Without pupil dilation; 848x848px.
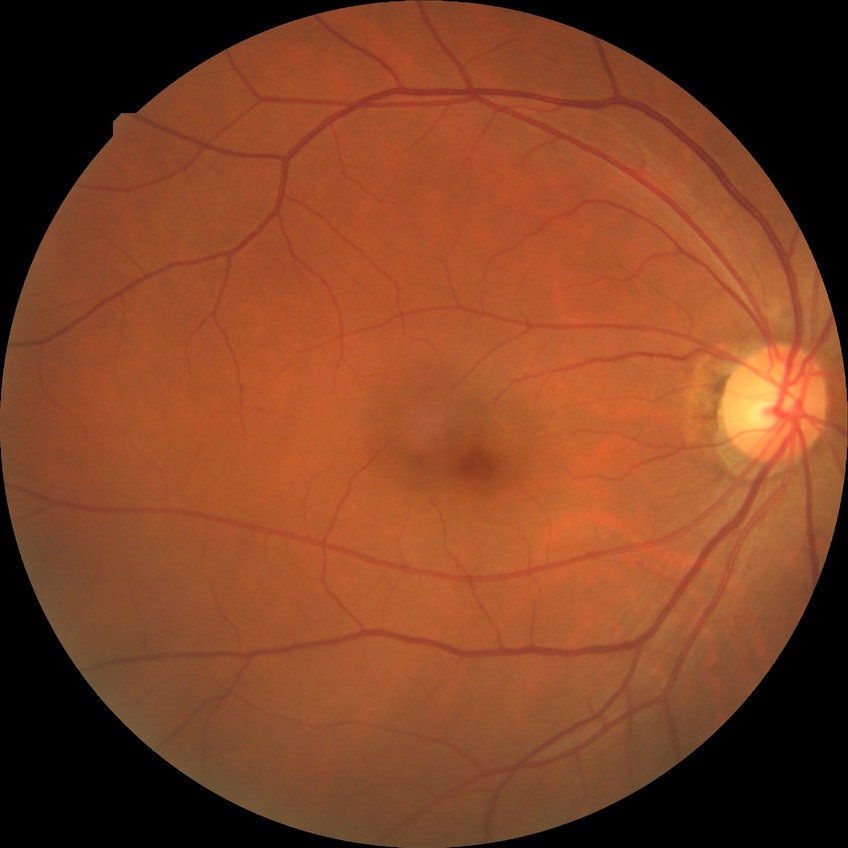
modified Davis grading: no diabetic retinopathy.